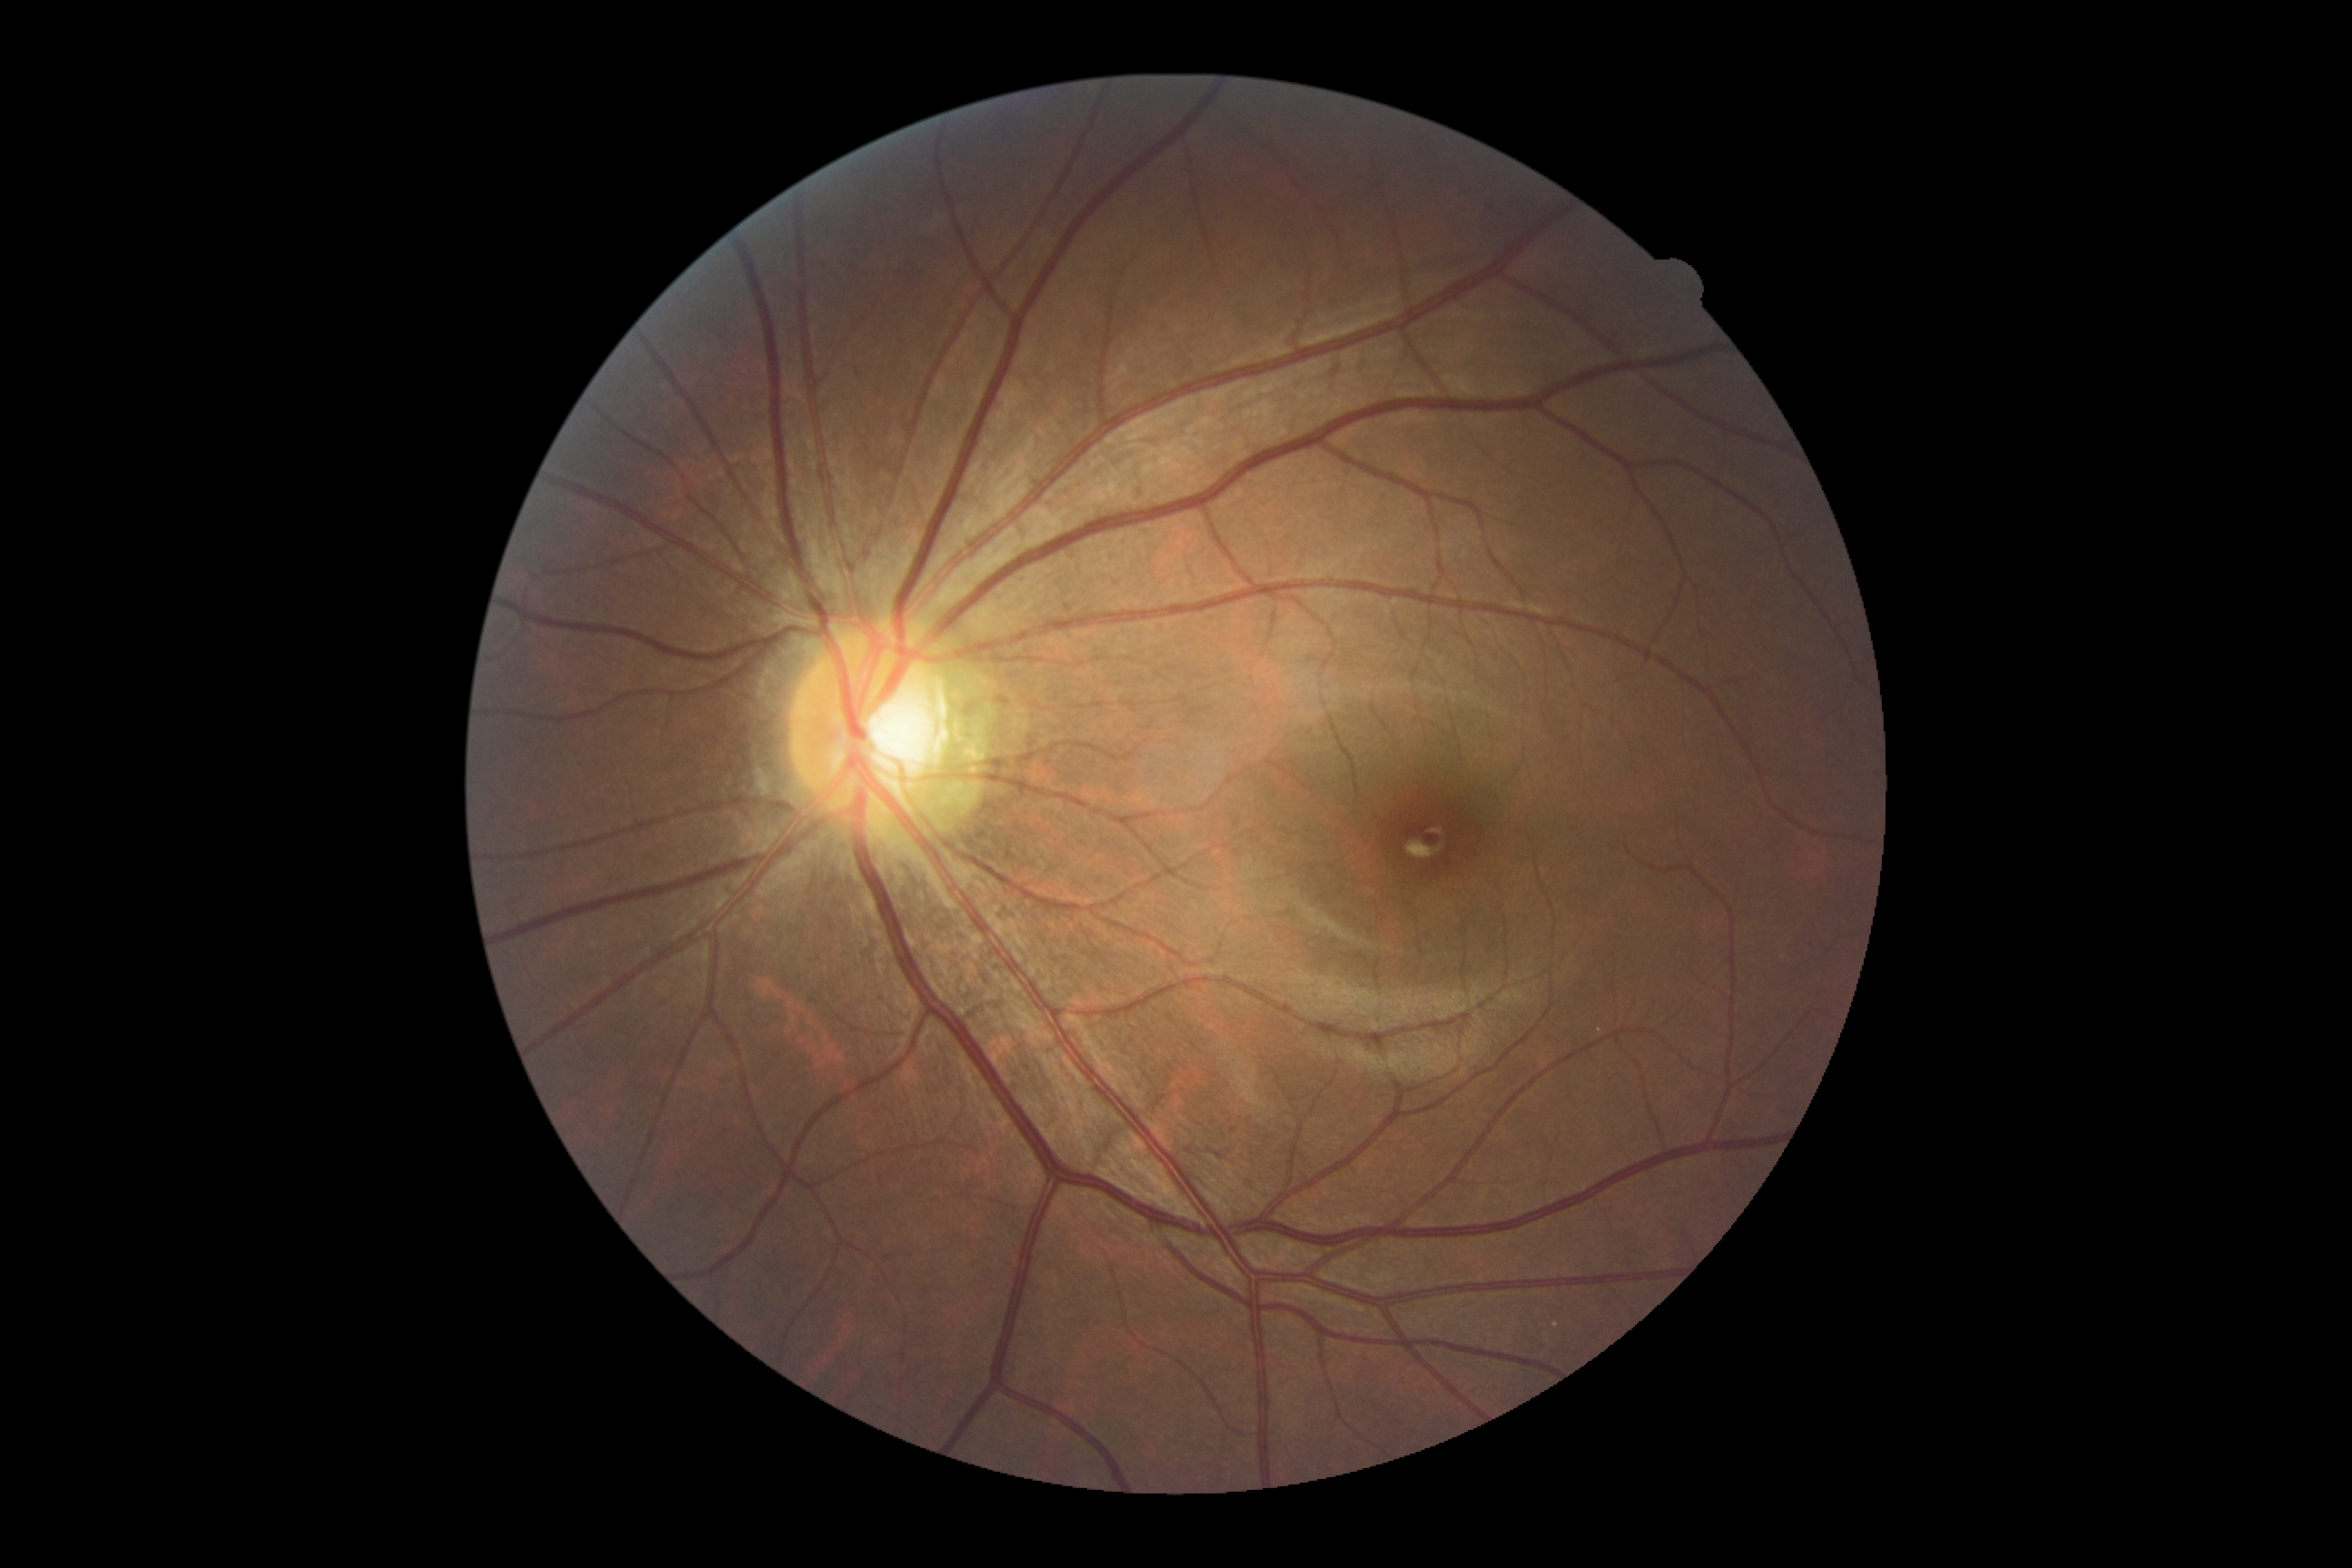 Annotations:
– diabetic retinopathy (DR) — grade 0 (no apparent retinopathy)